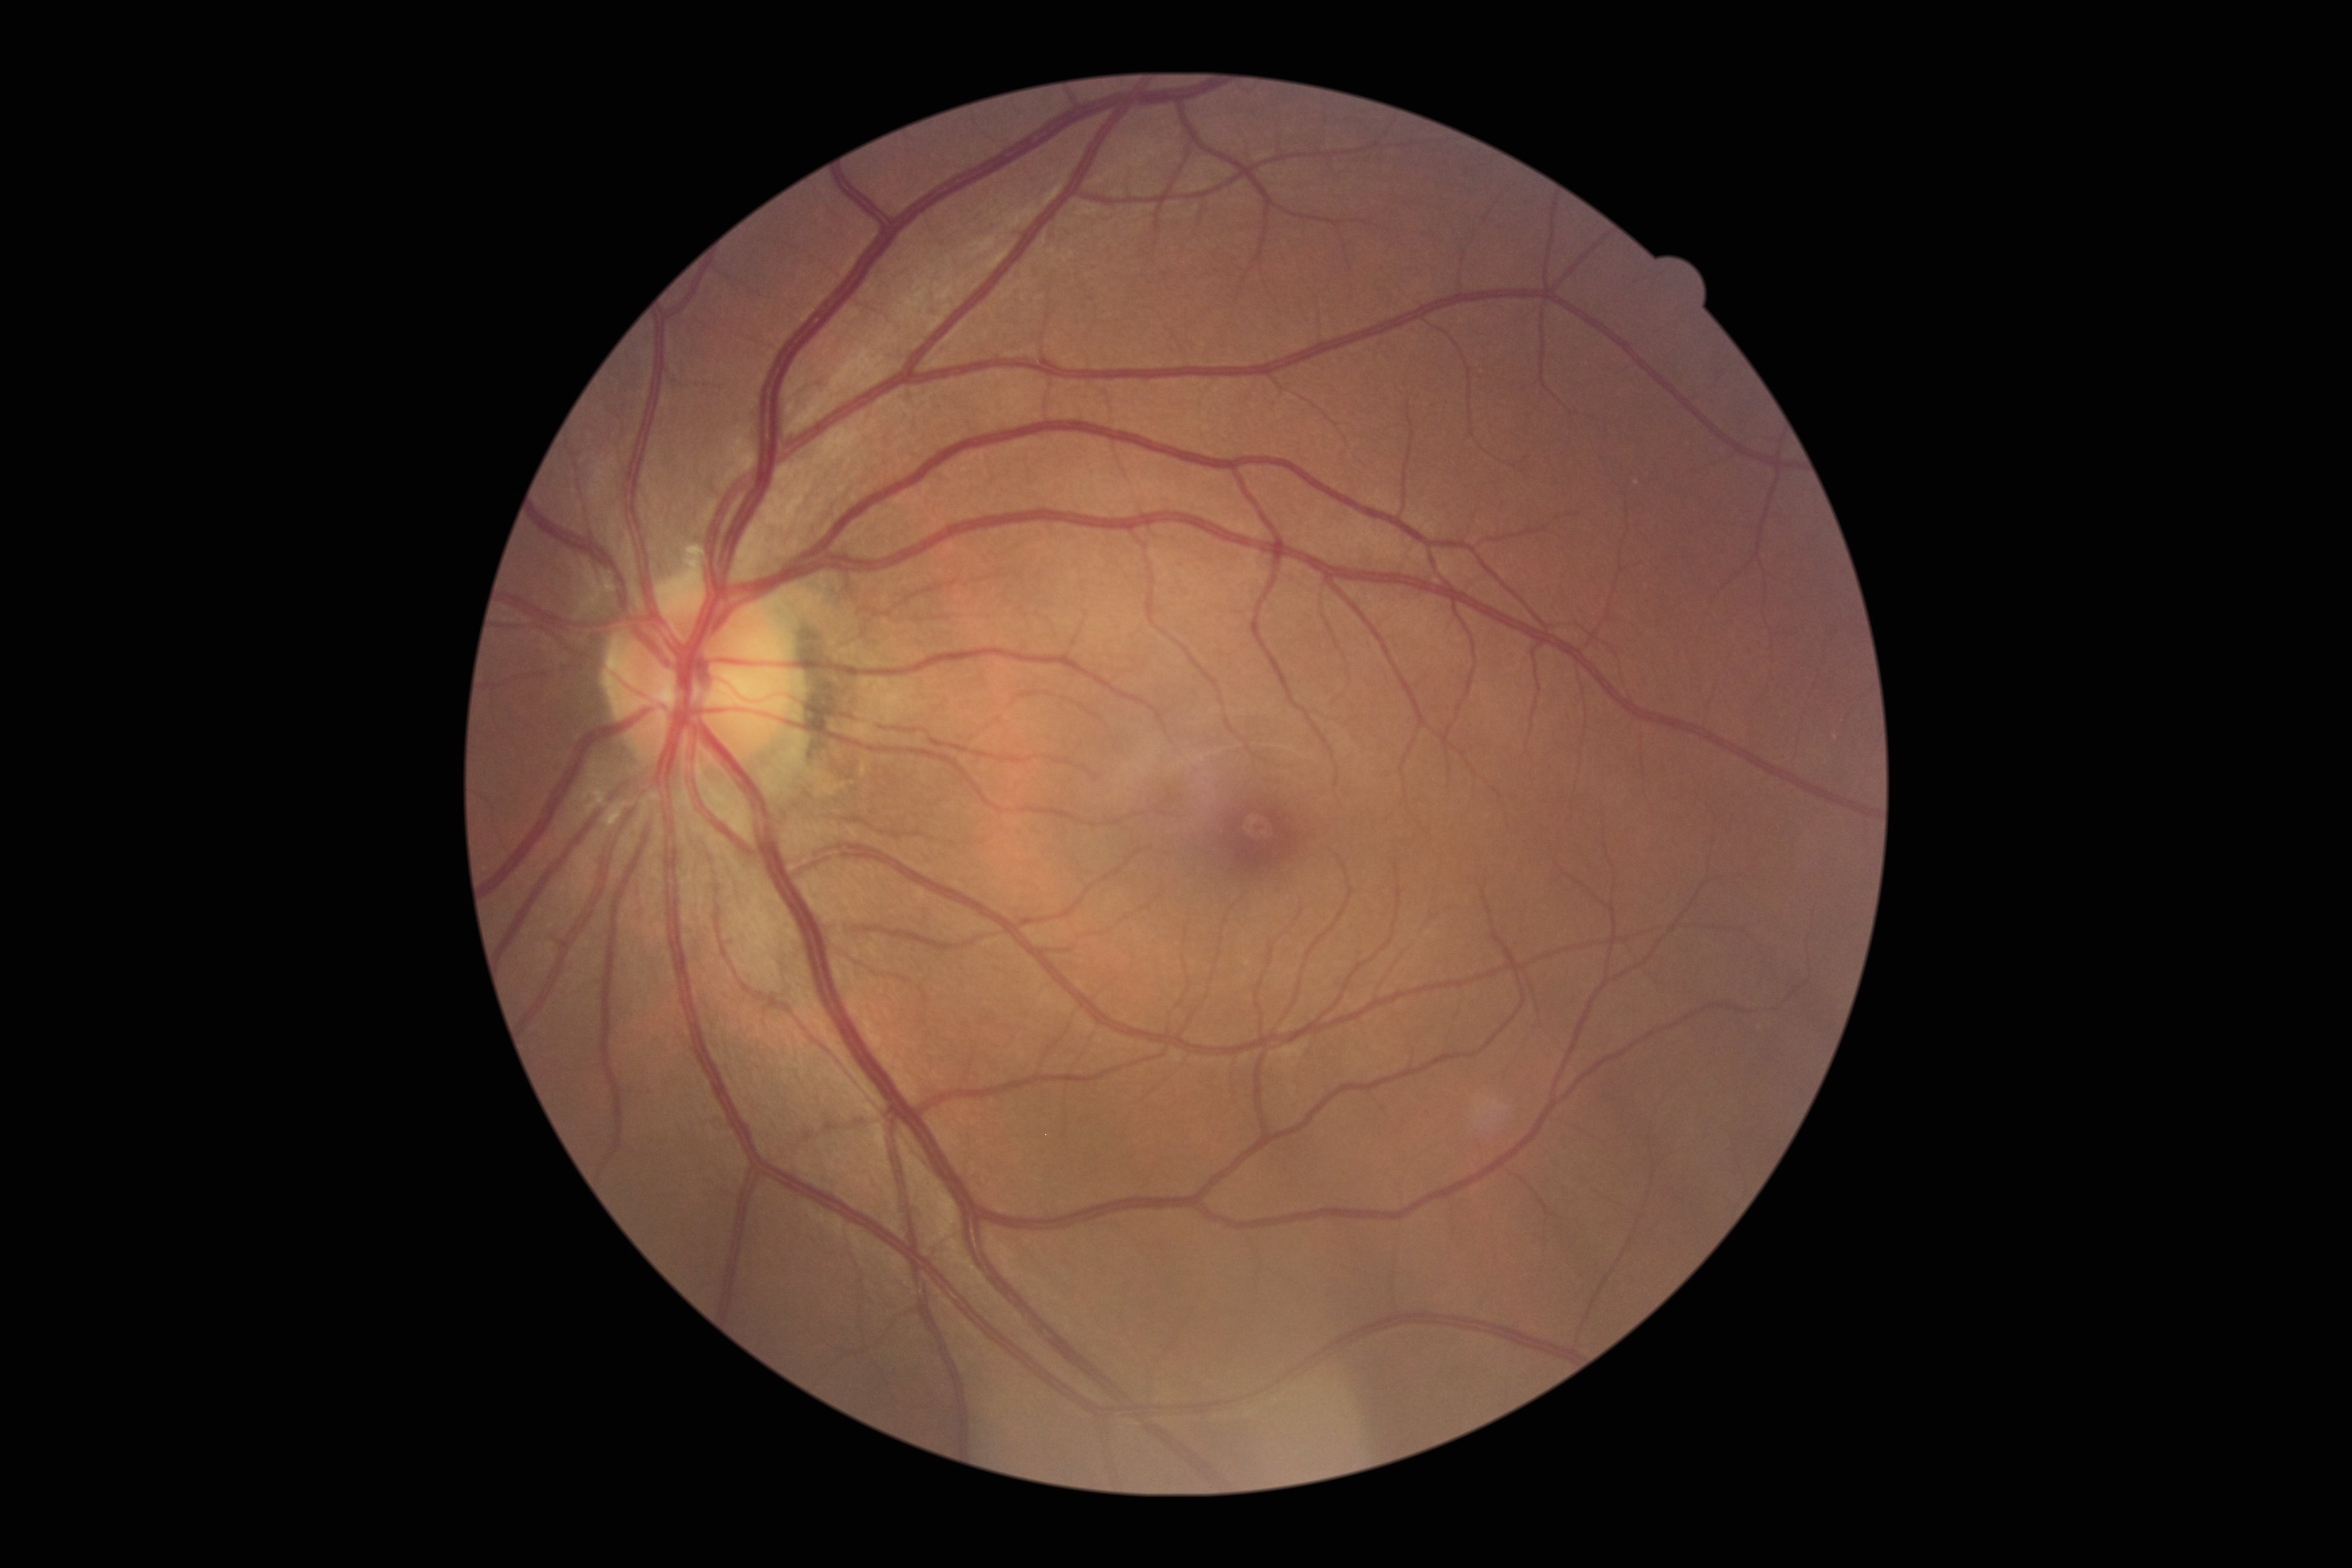
Diabetic retinopathy (DR) is grade 0 (no apparent retinopathy). No diabetic retinal disease findings.